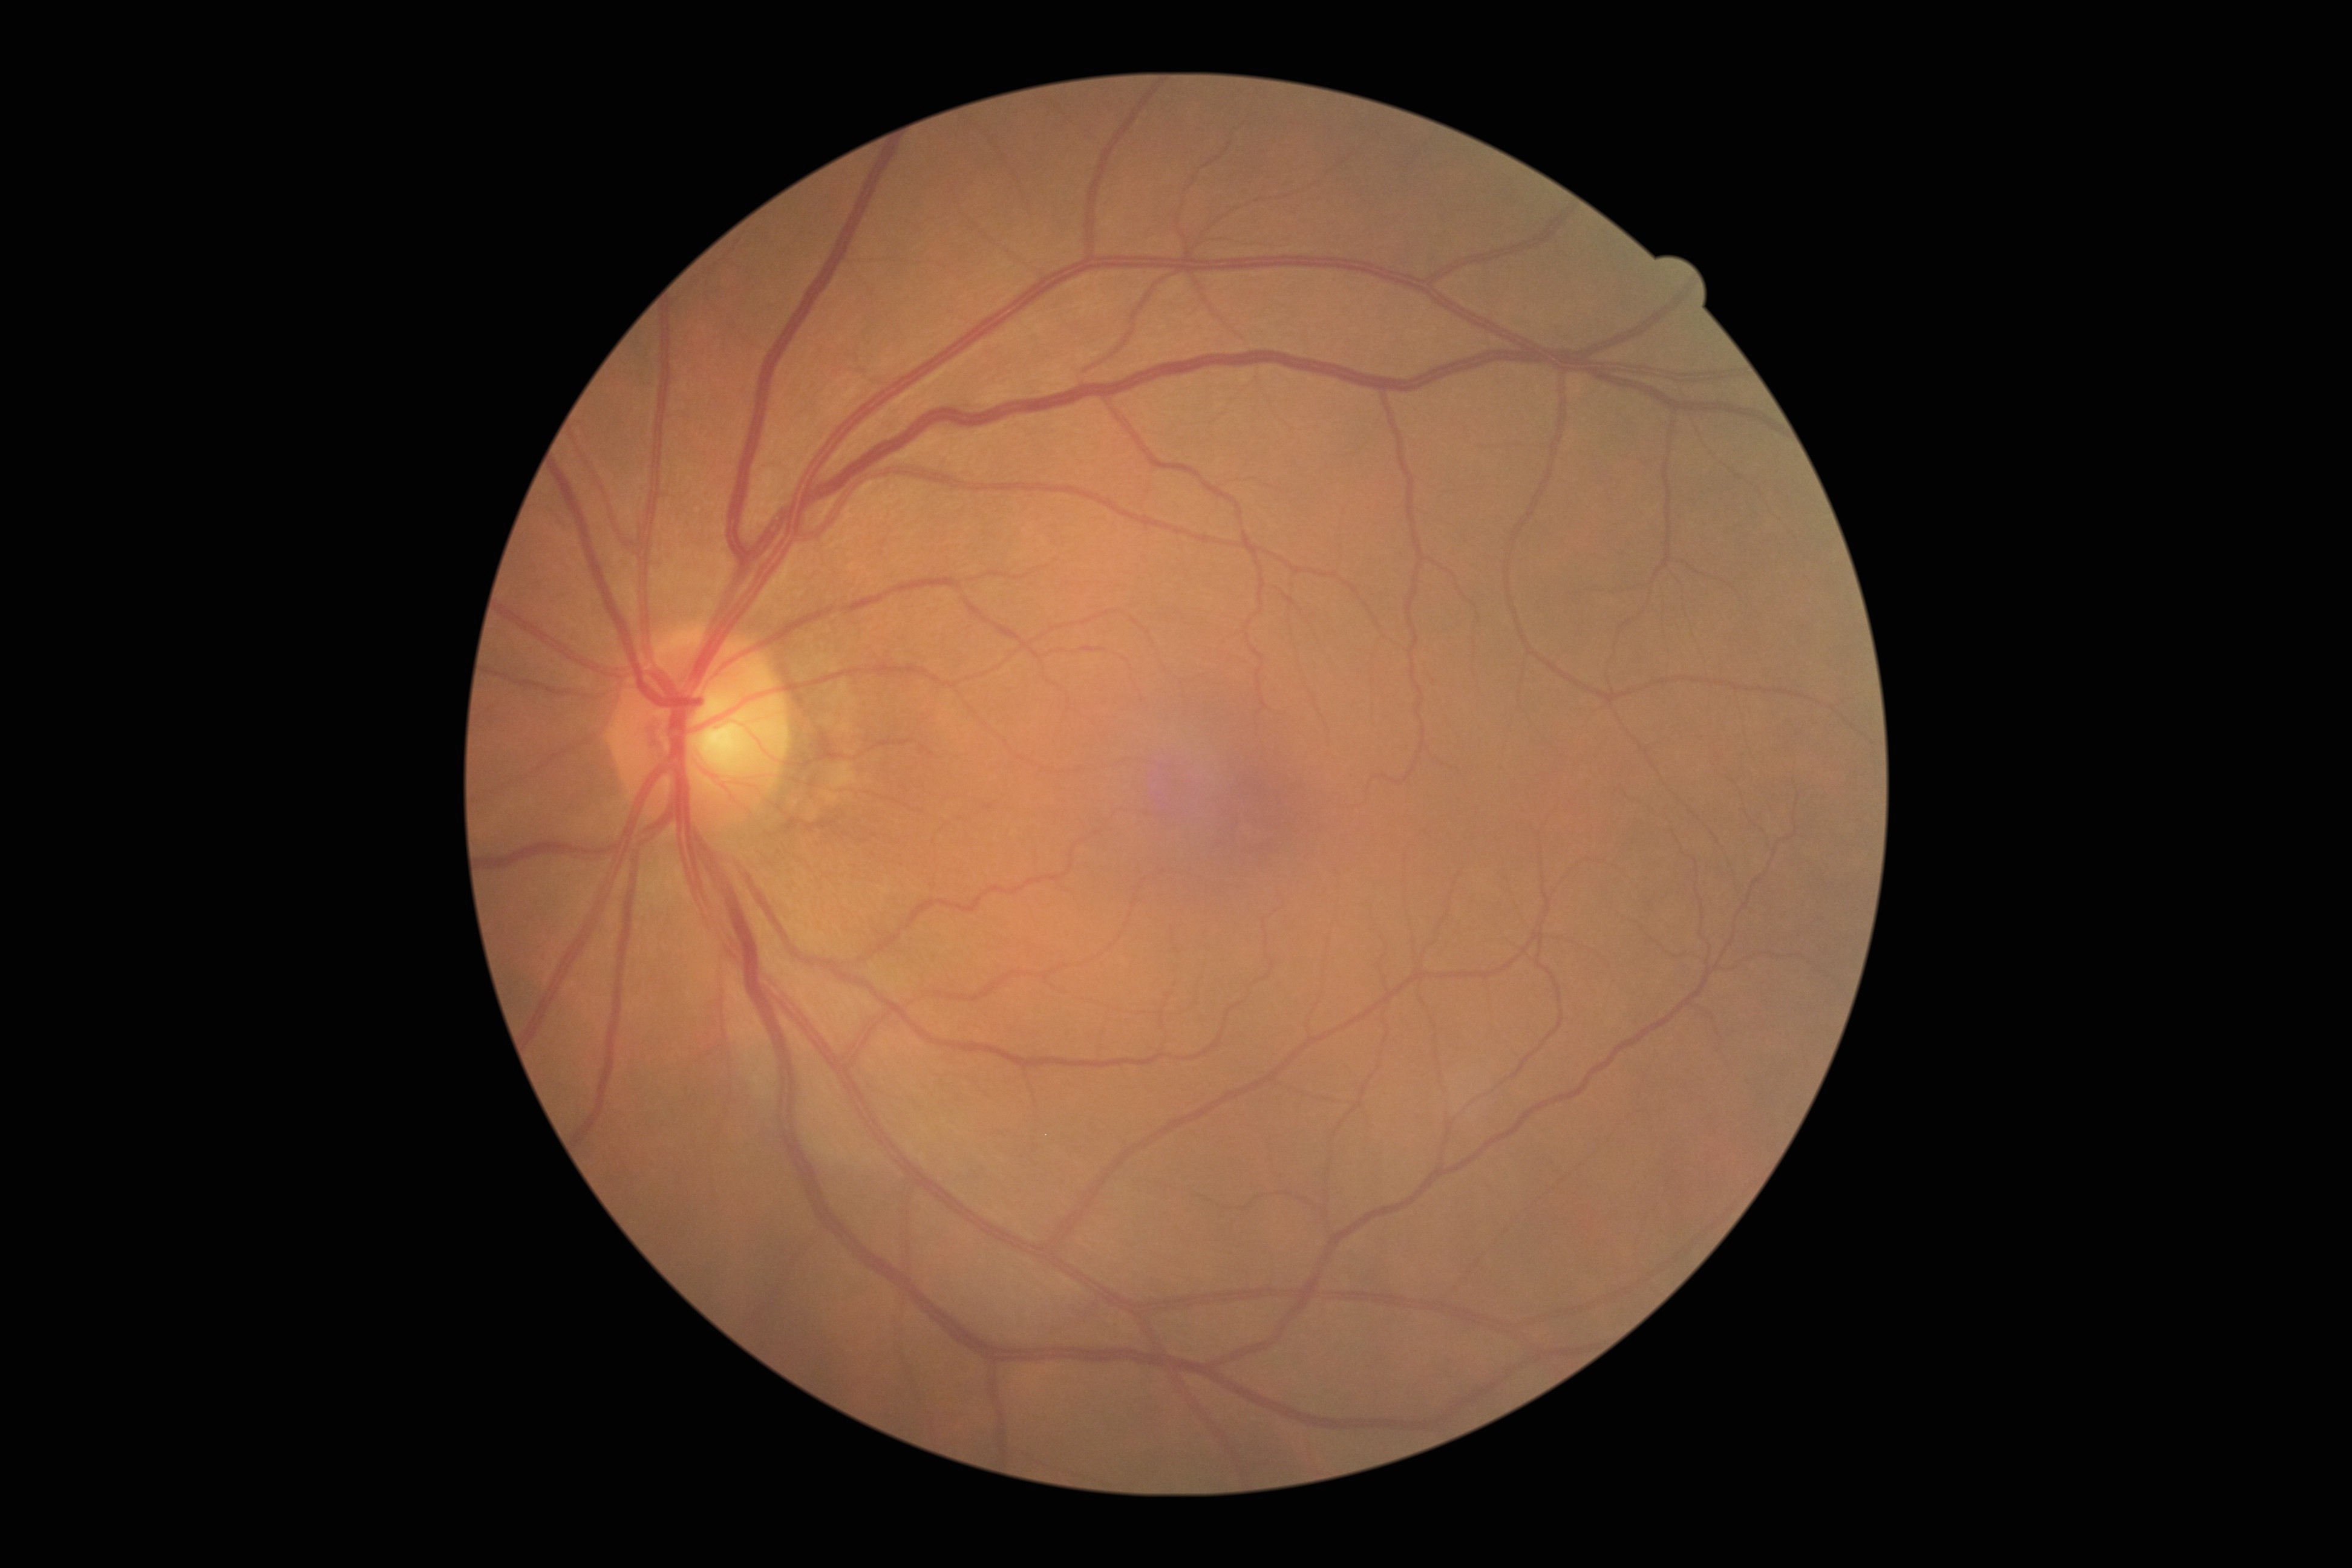
Diabetic retinopathy grade is 0.